45° FOV: 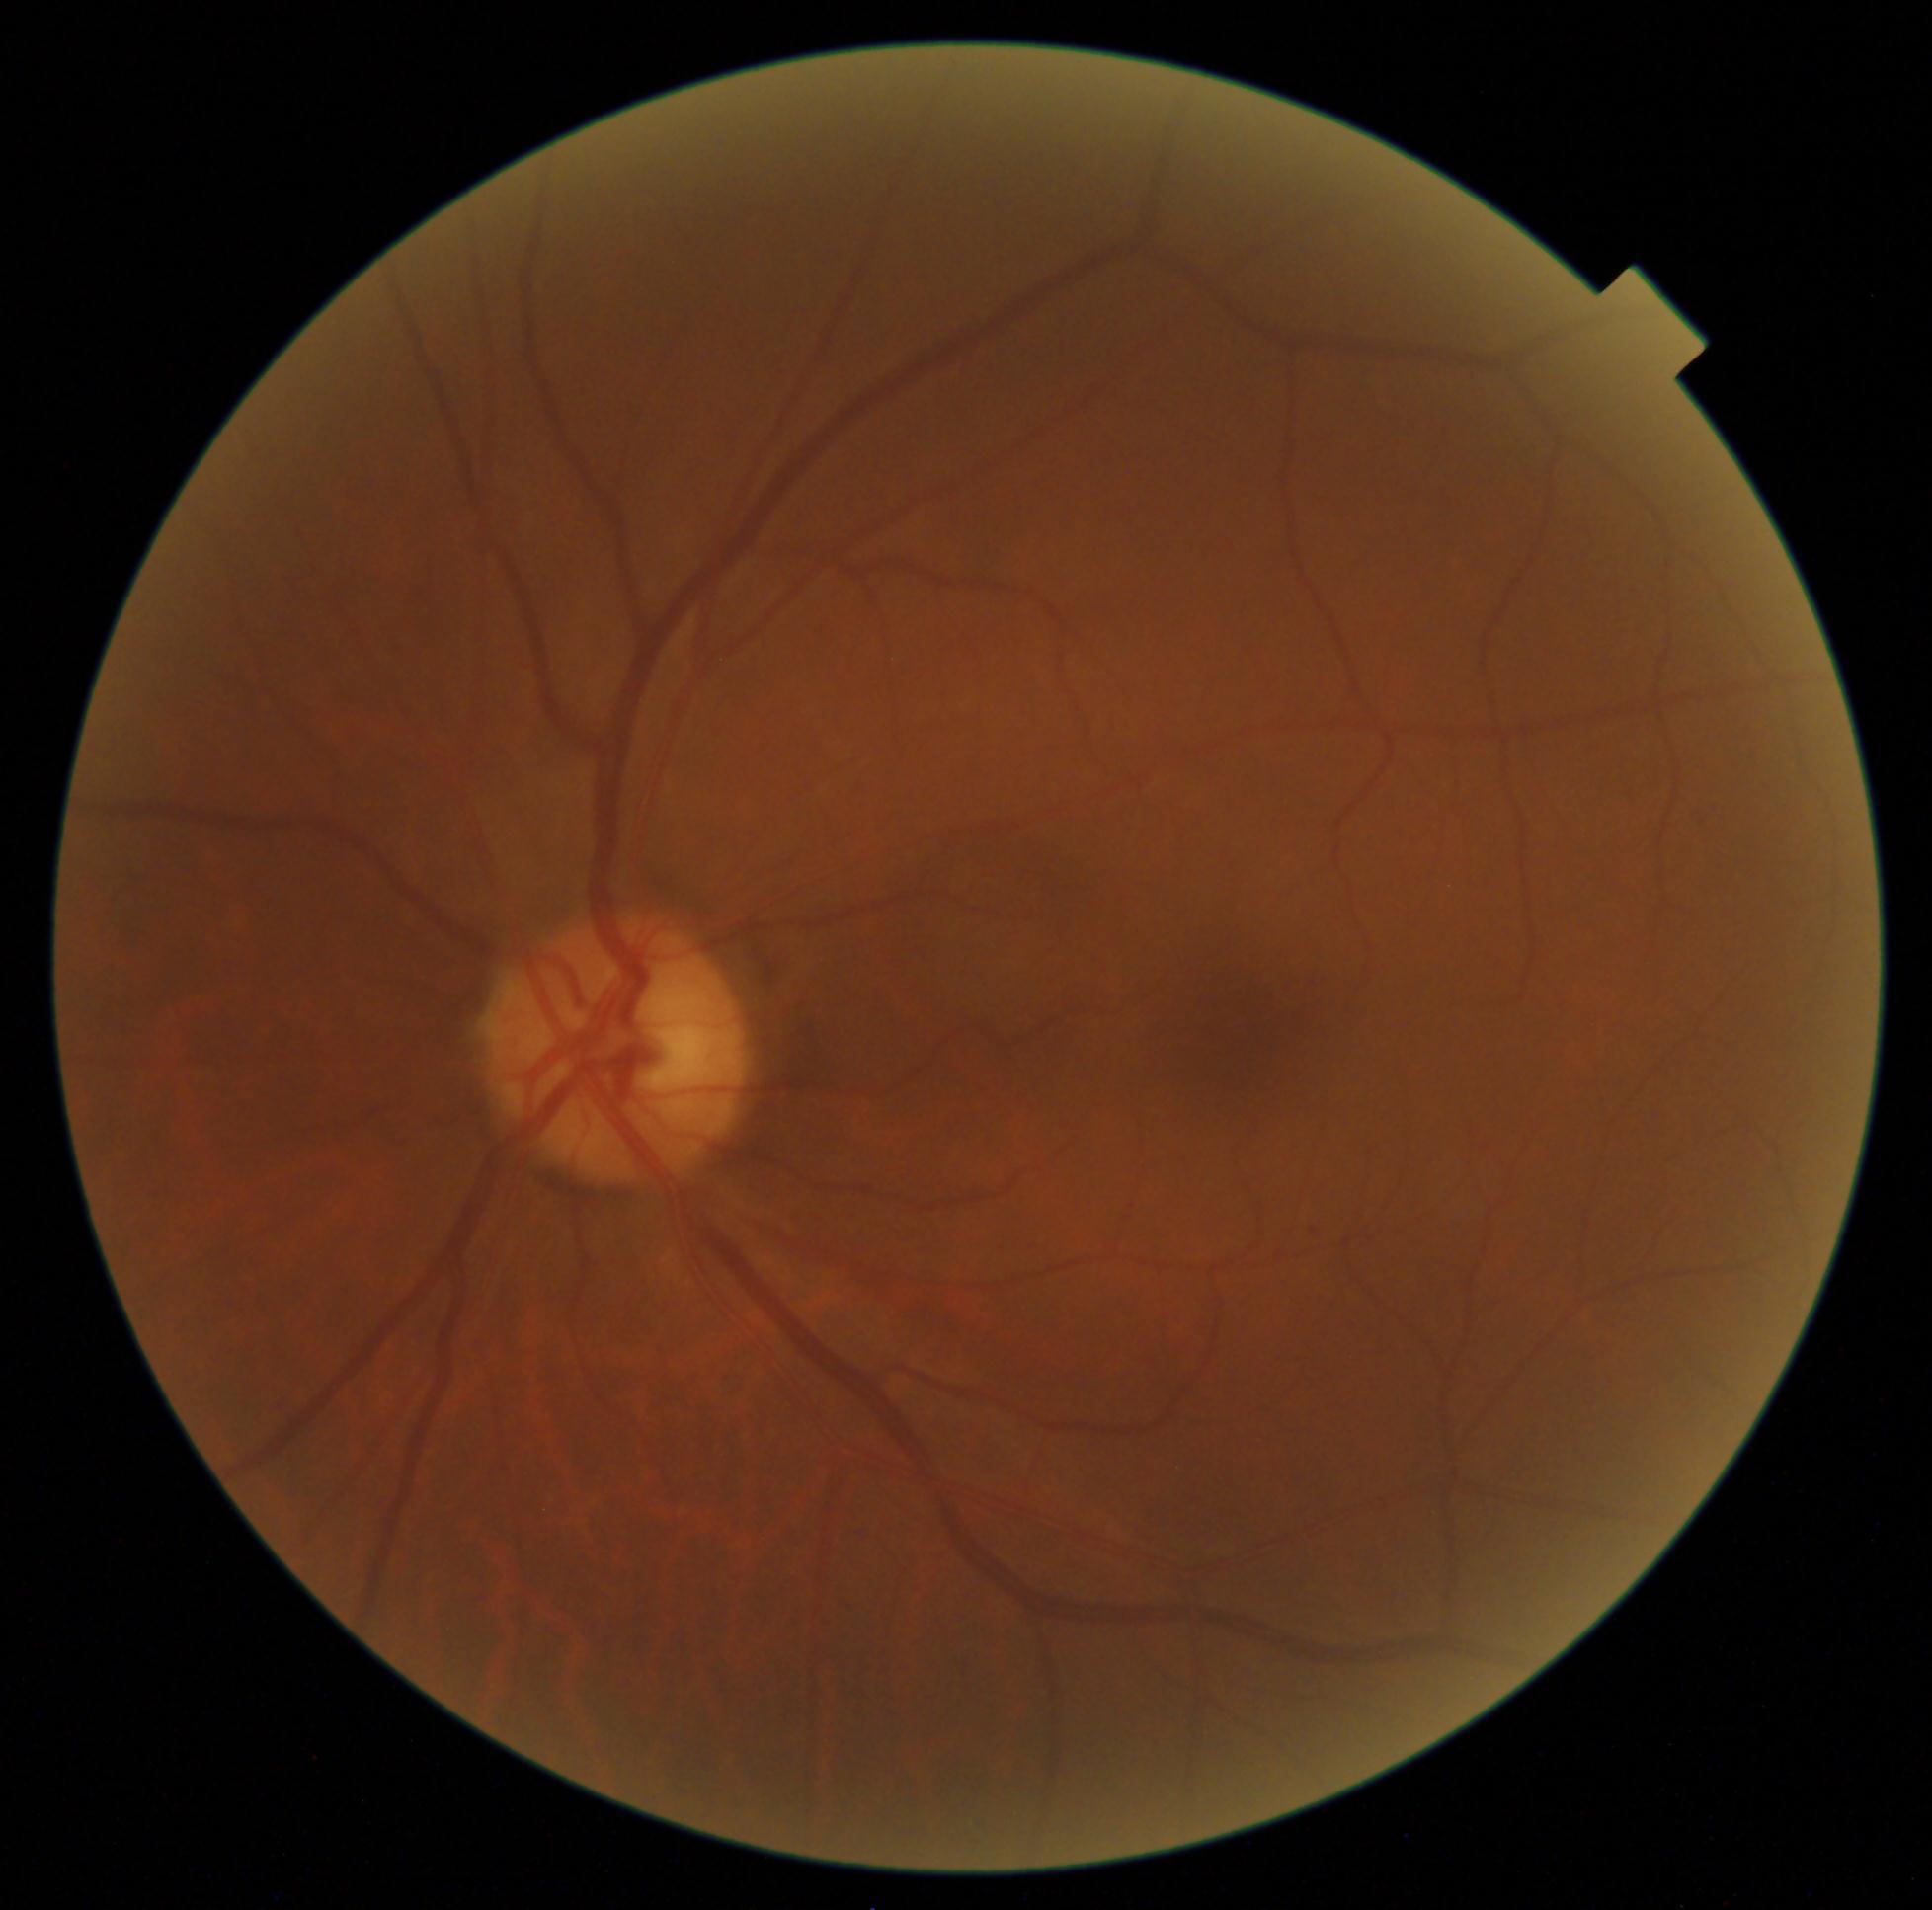 diabetic retinopathy severity@0 — no visible signs of diabetic retinopathy.